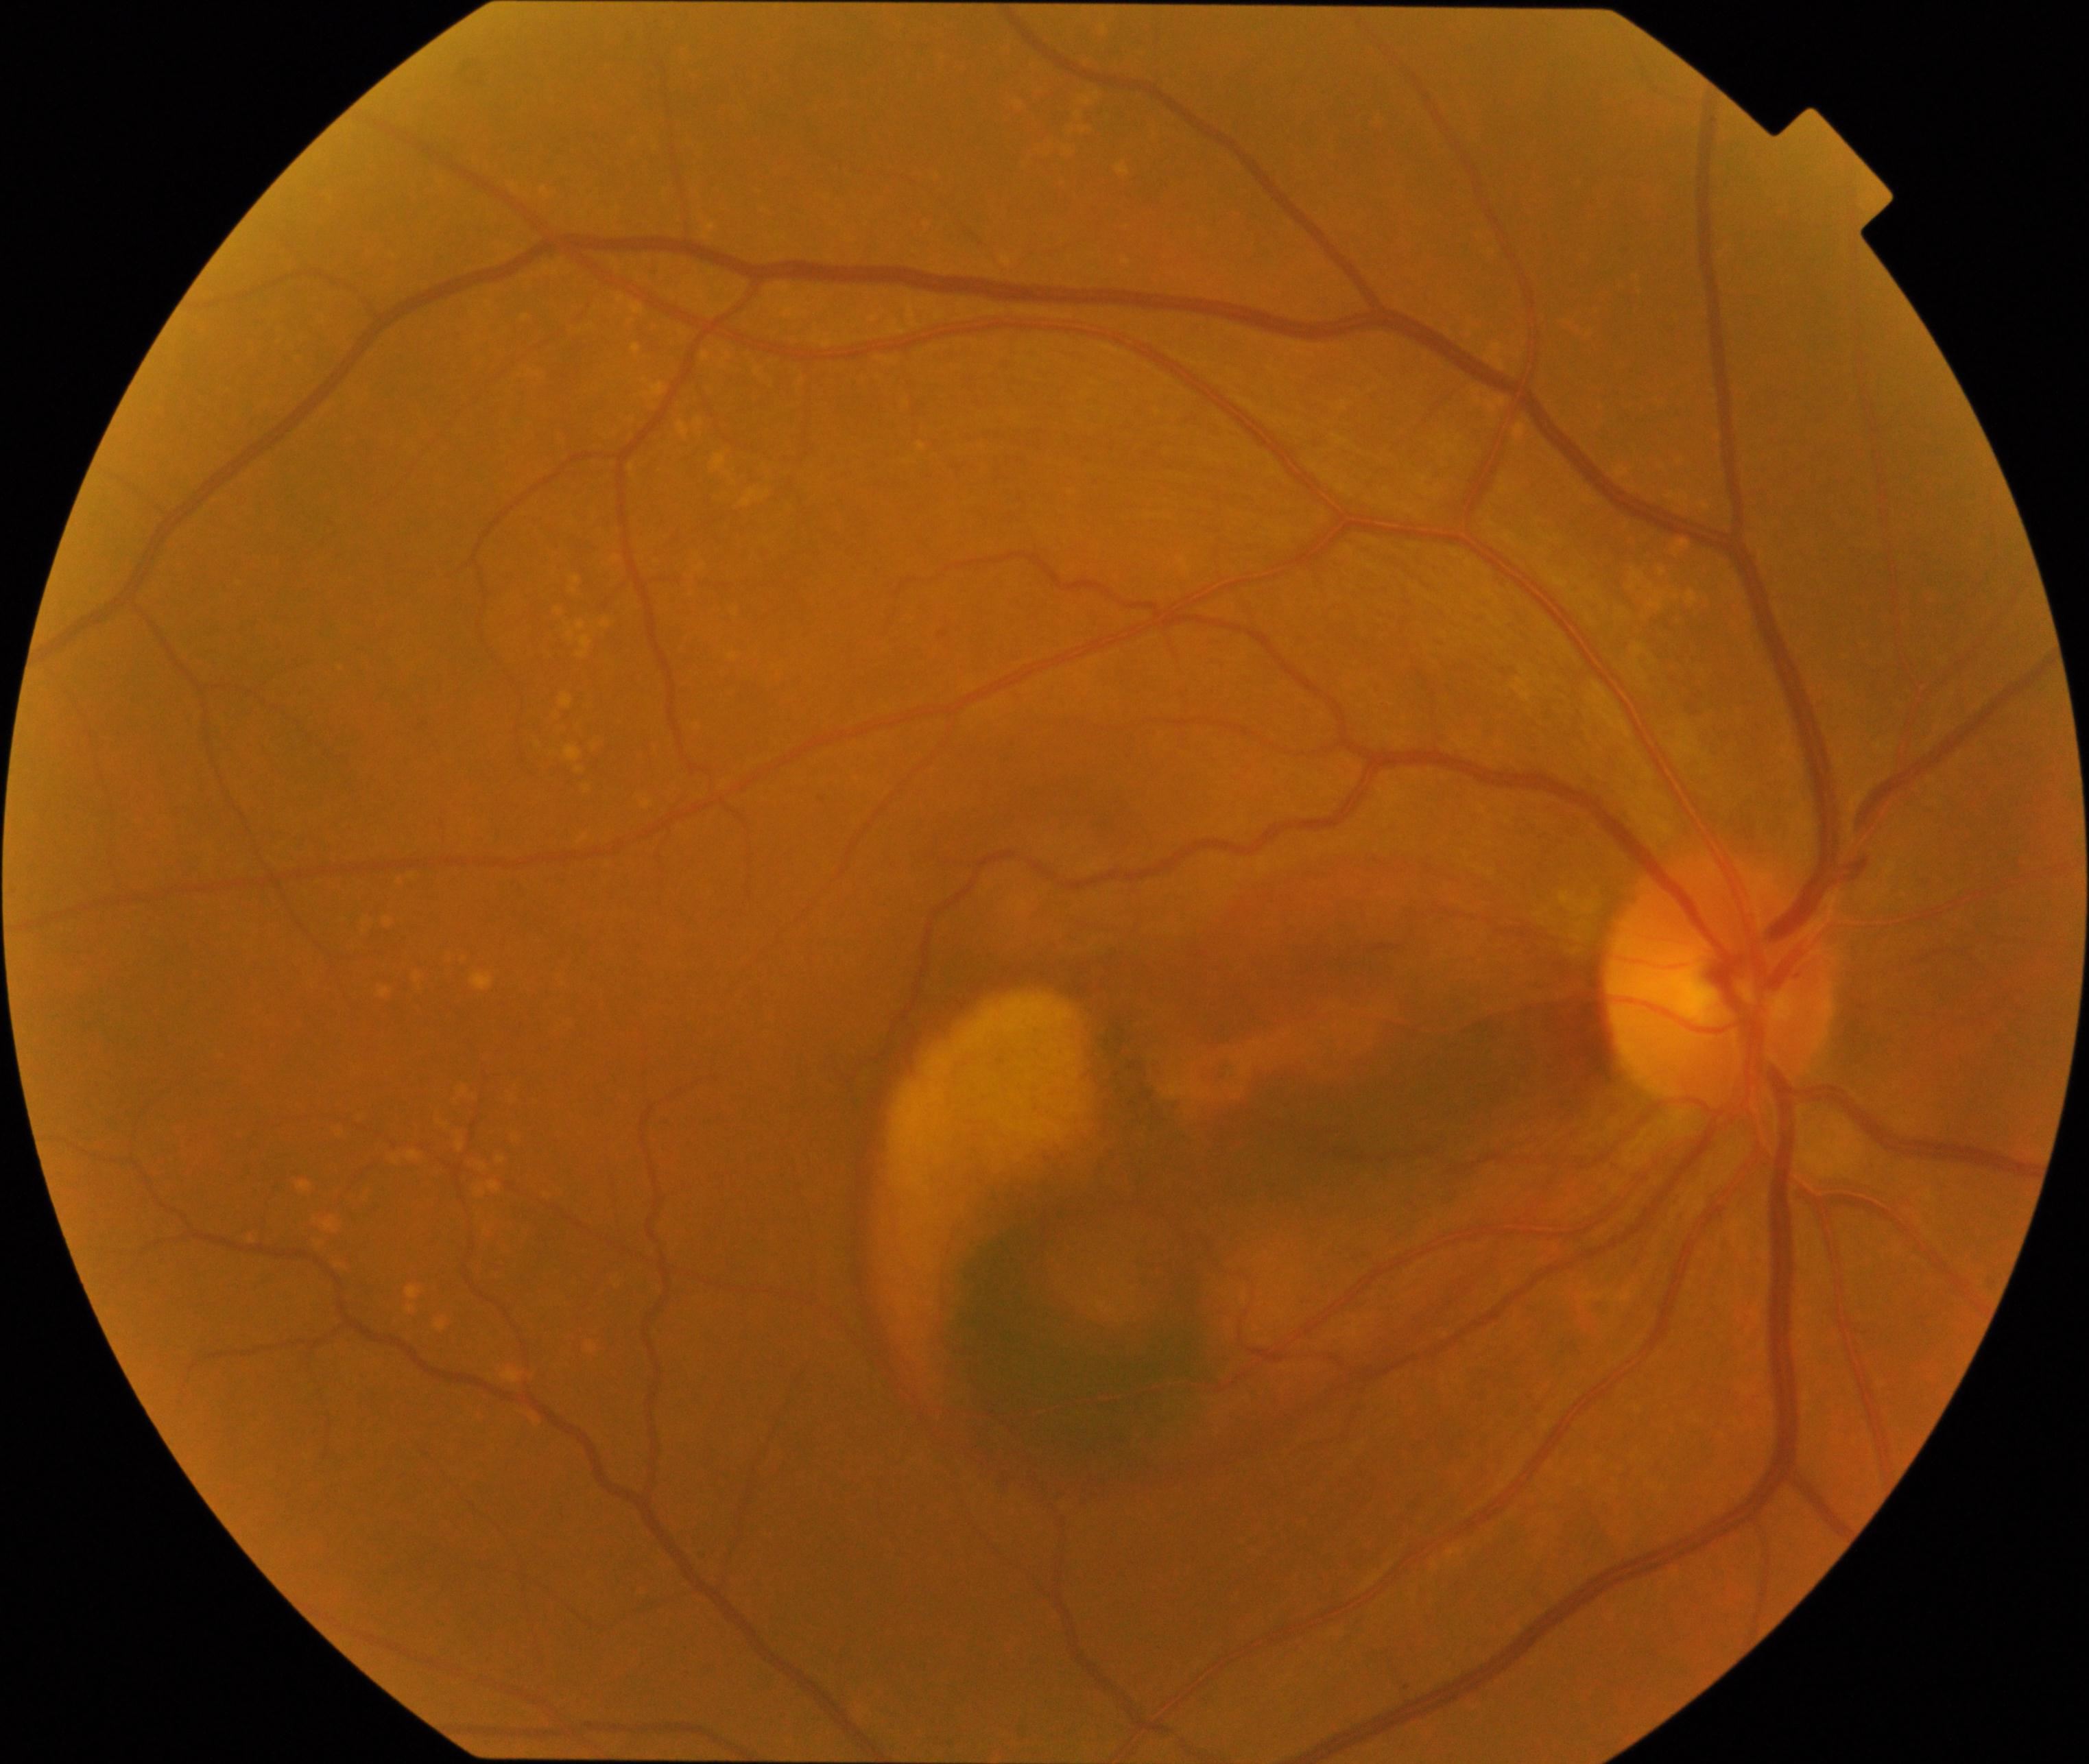

The image shows maculopathy.